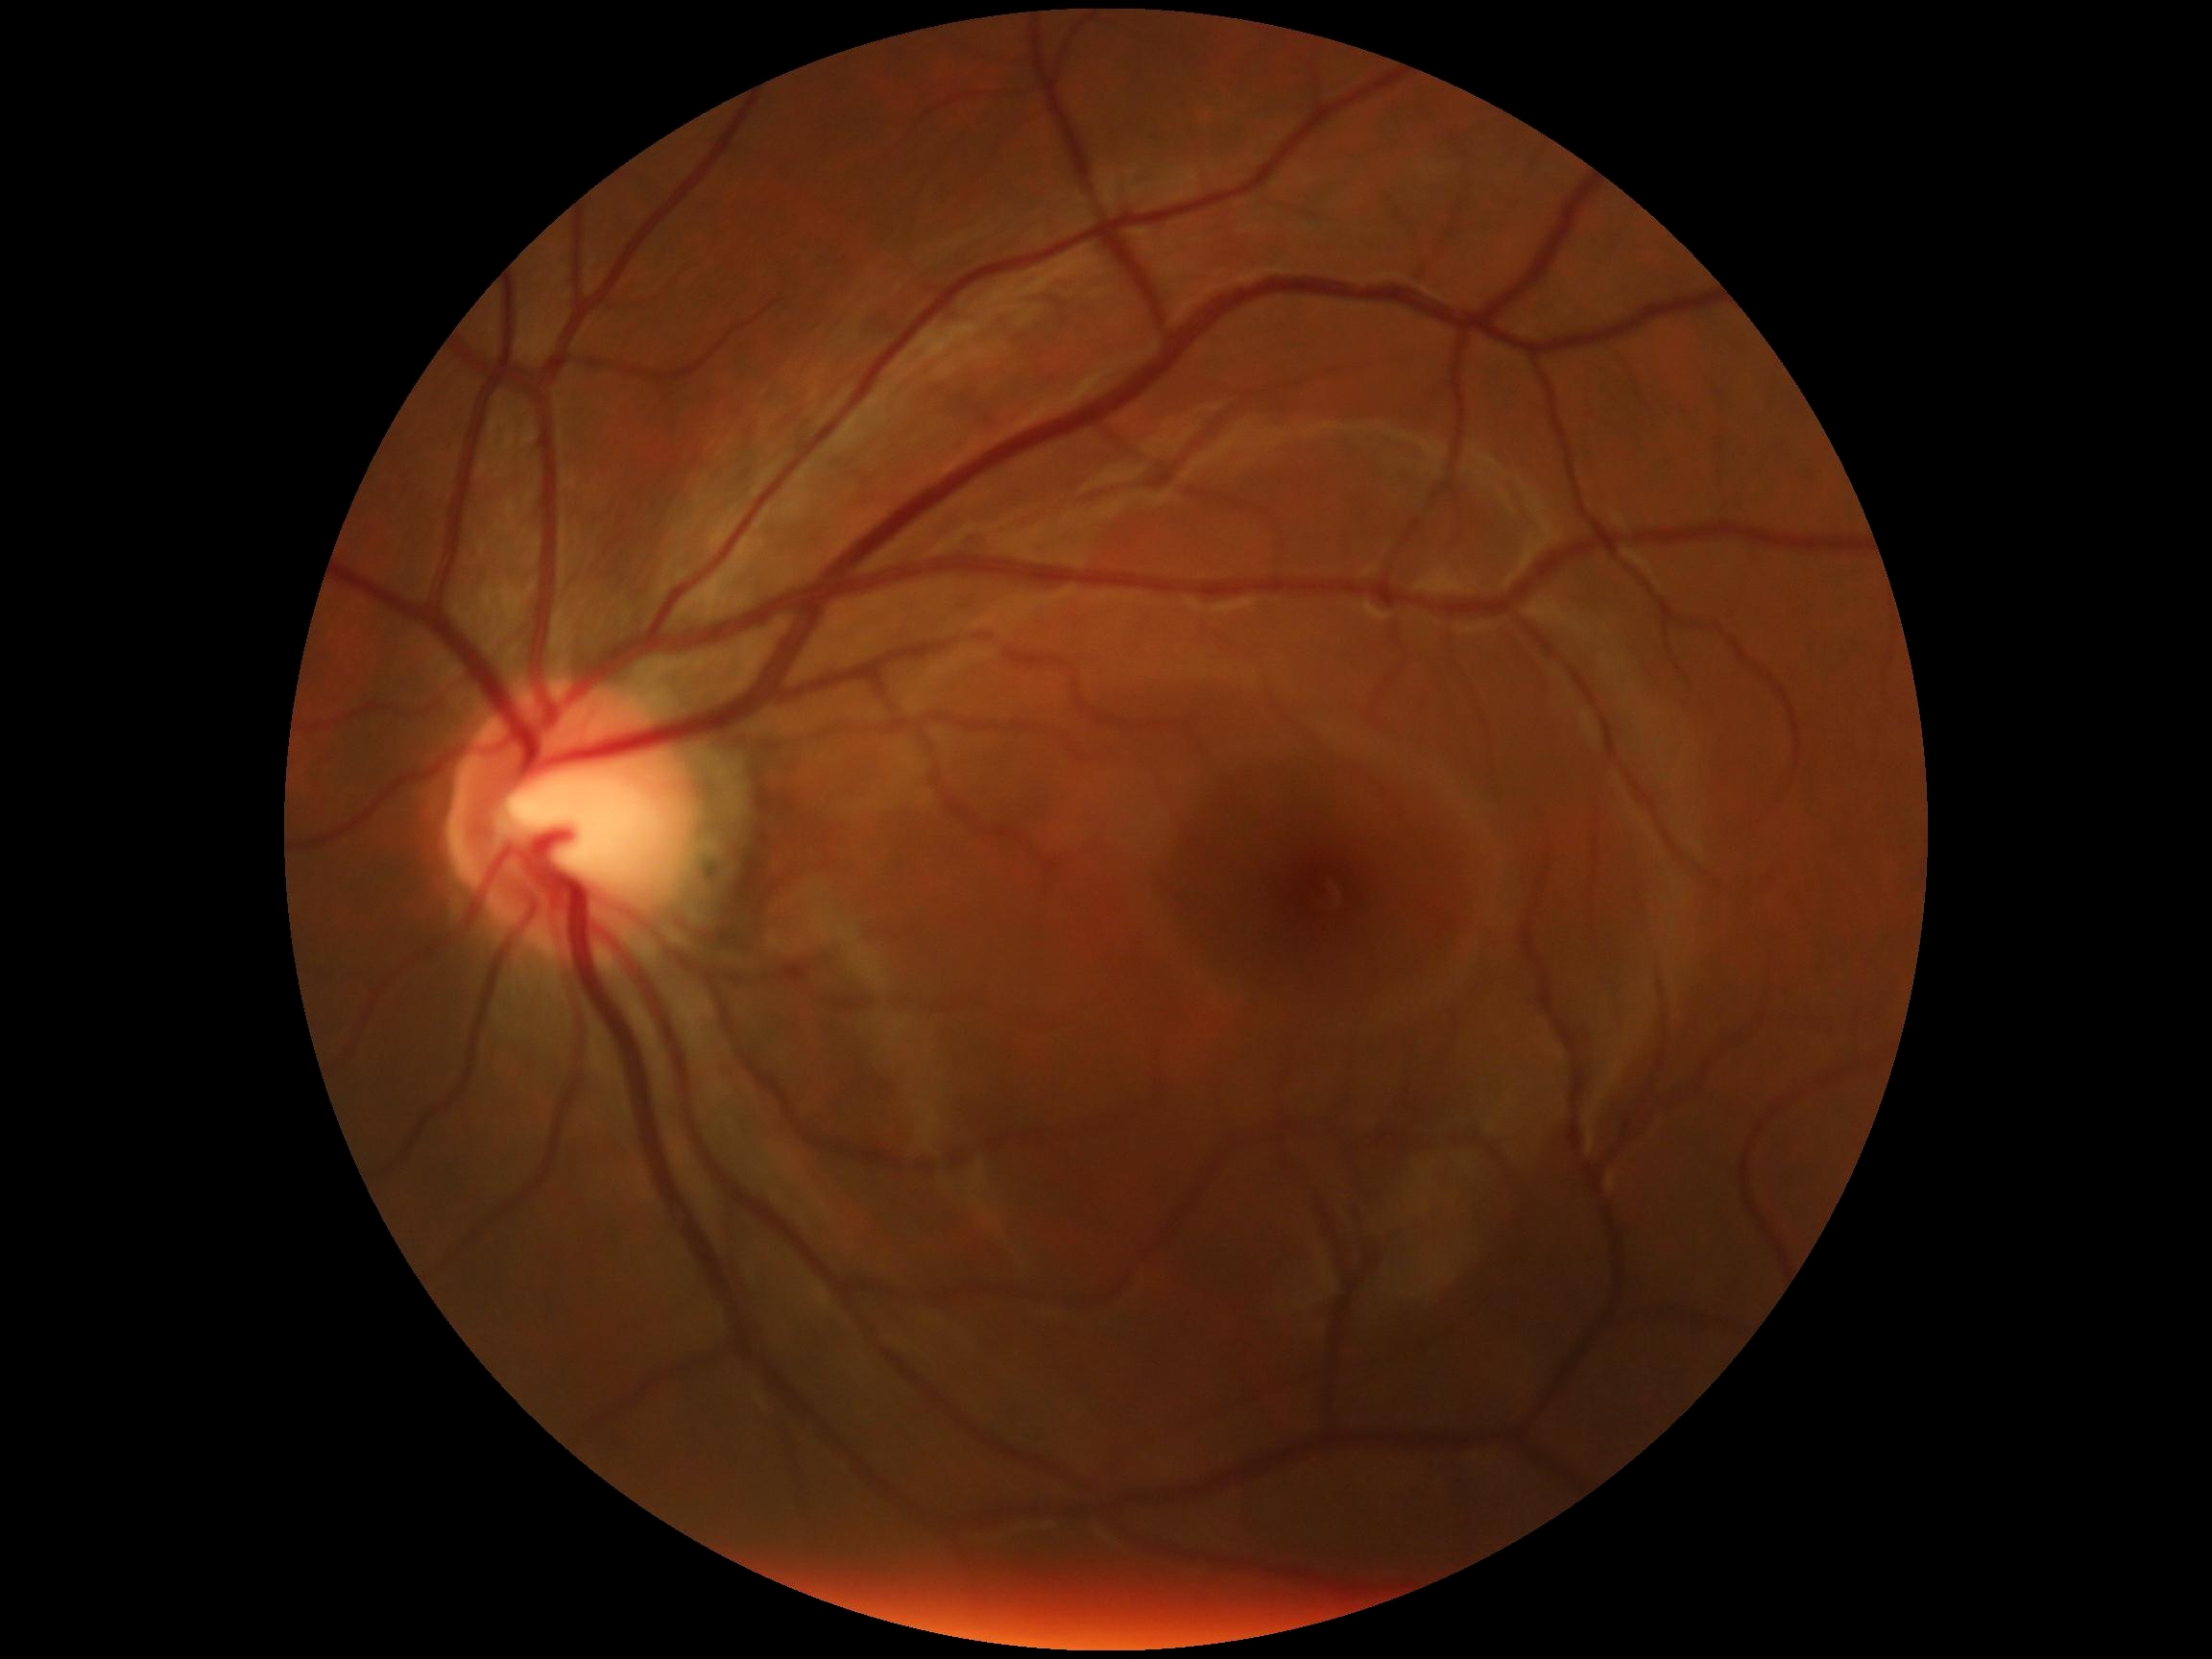 diabetic retinopathy severity: no apparent diabetic retinopathy (grade 0)